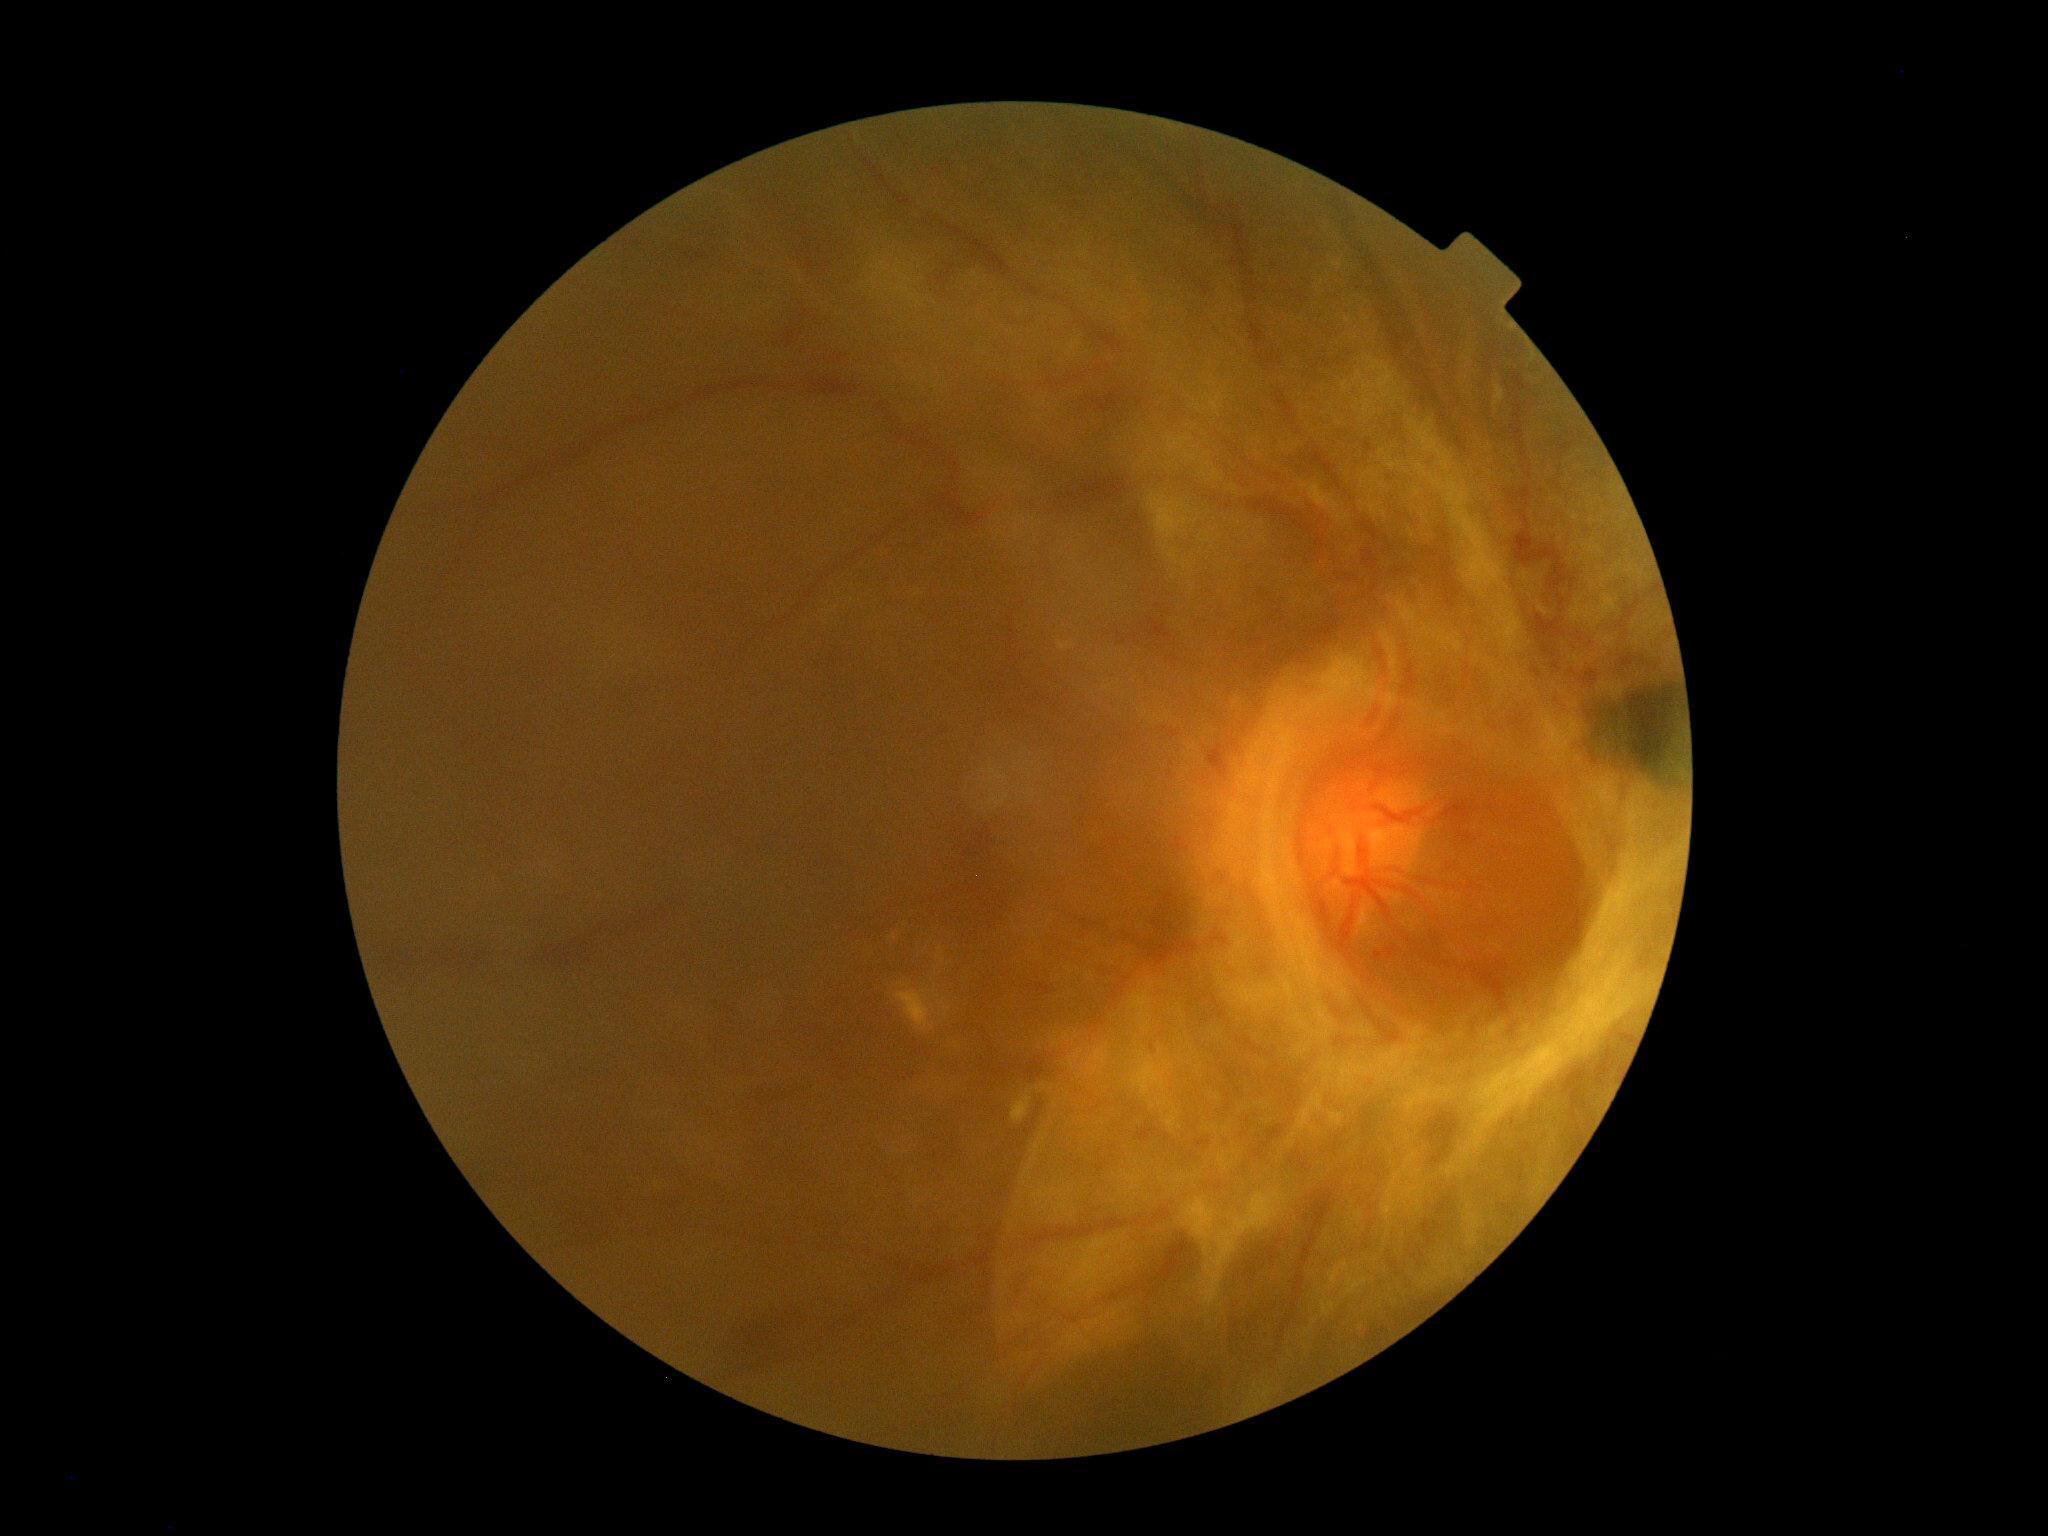
DR class: proliferative diabetic retinopathy.
DR severity: 4/4.